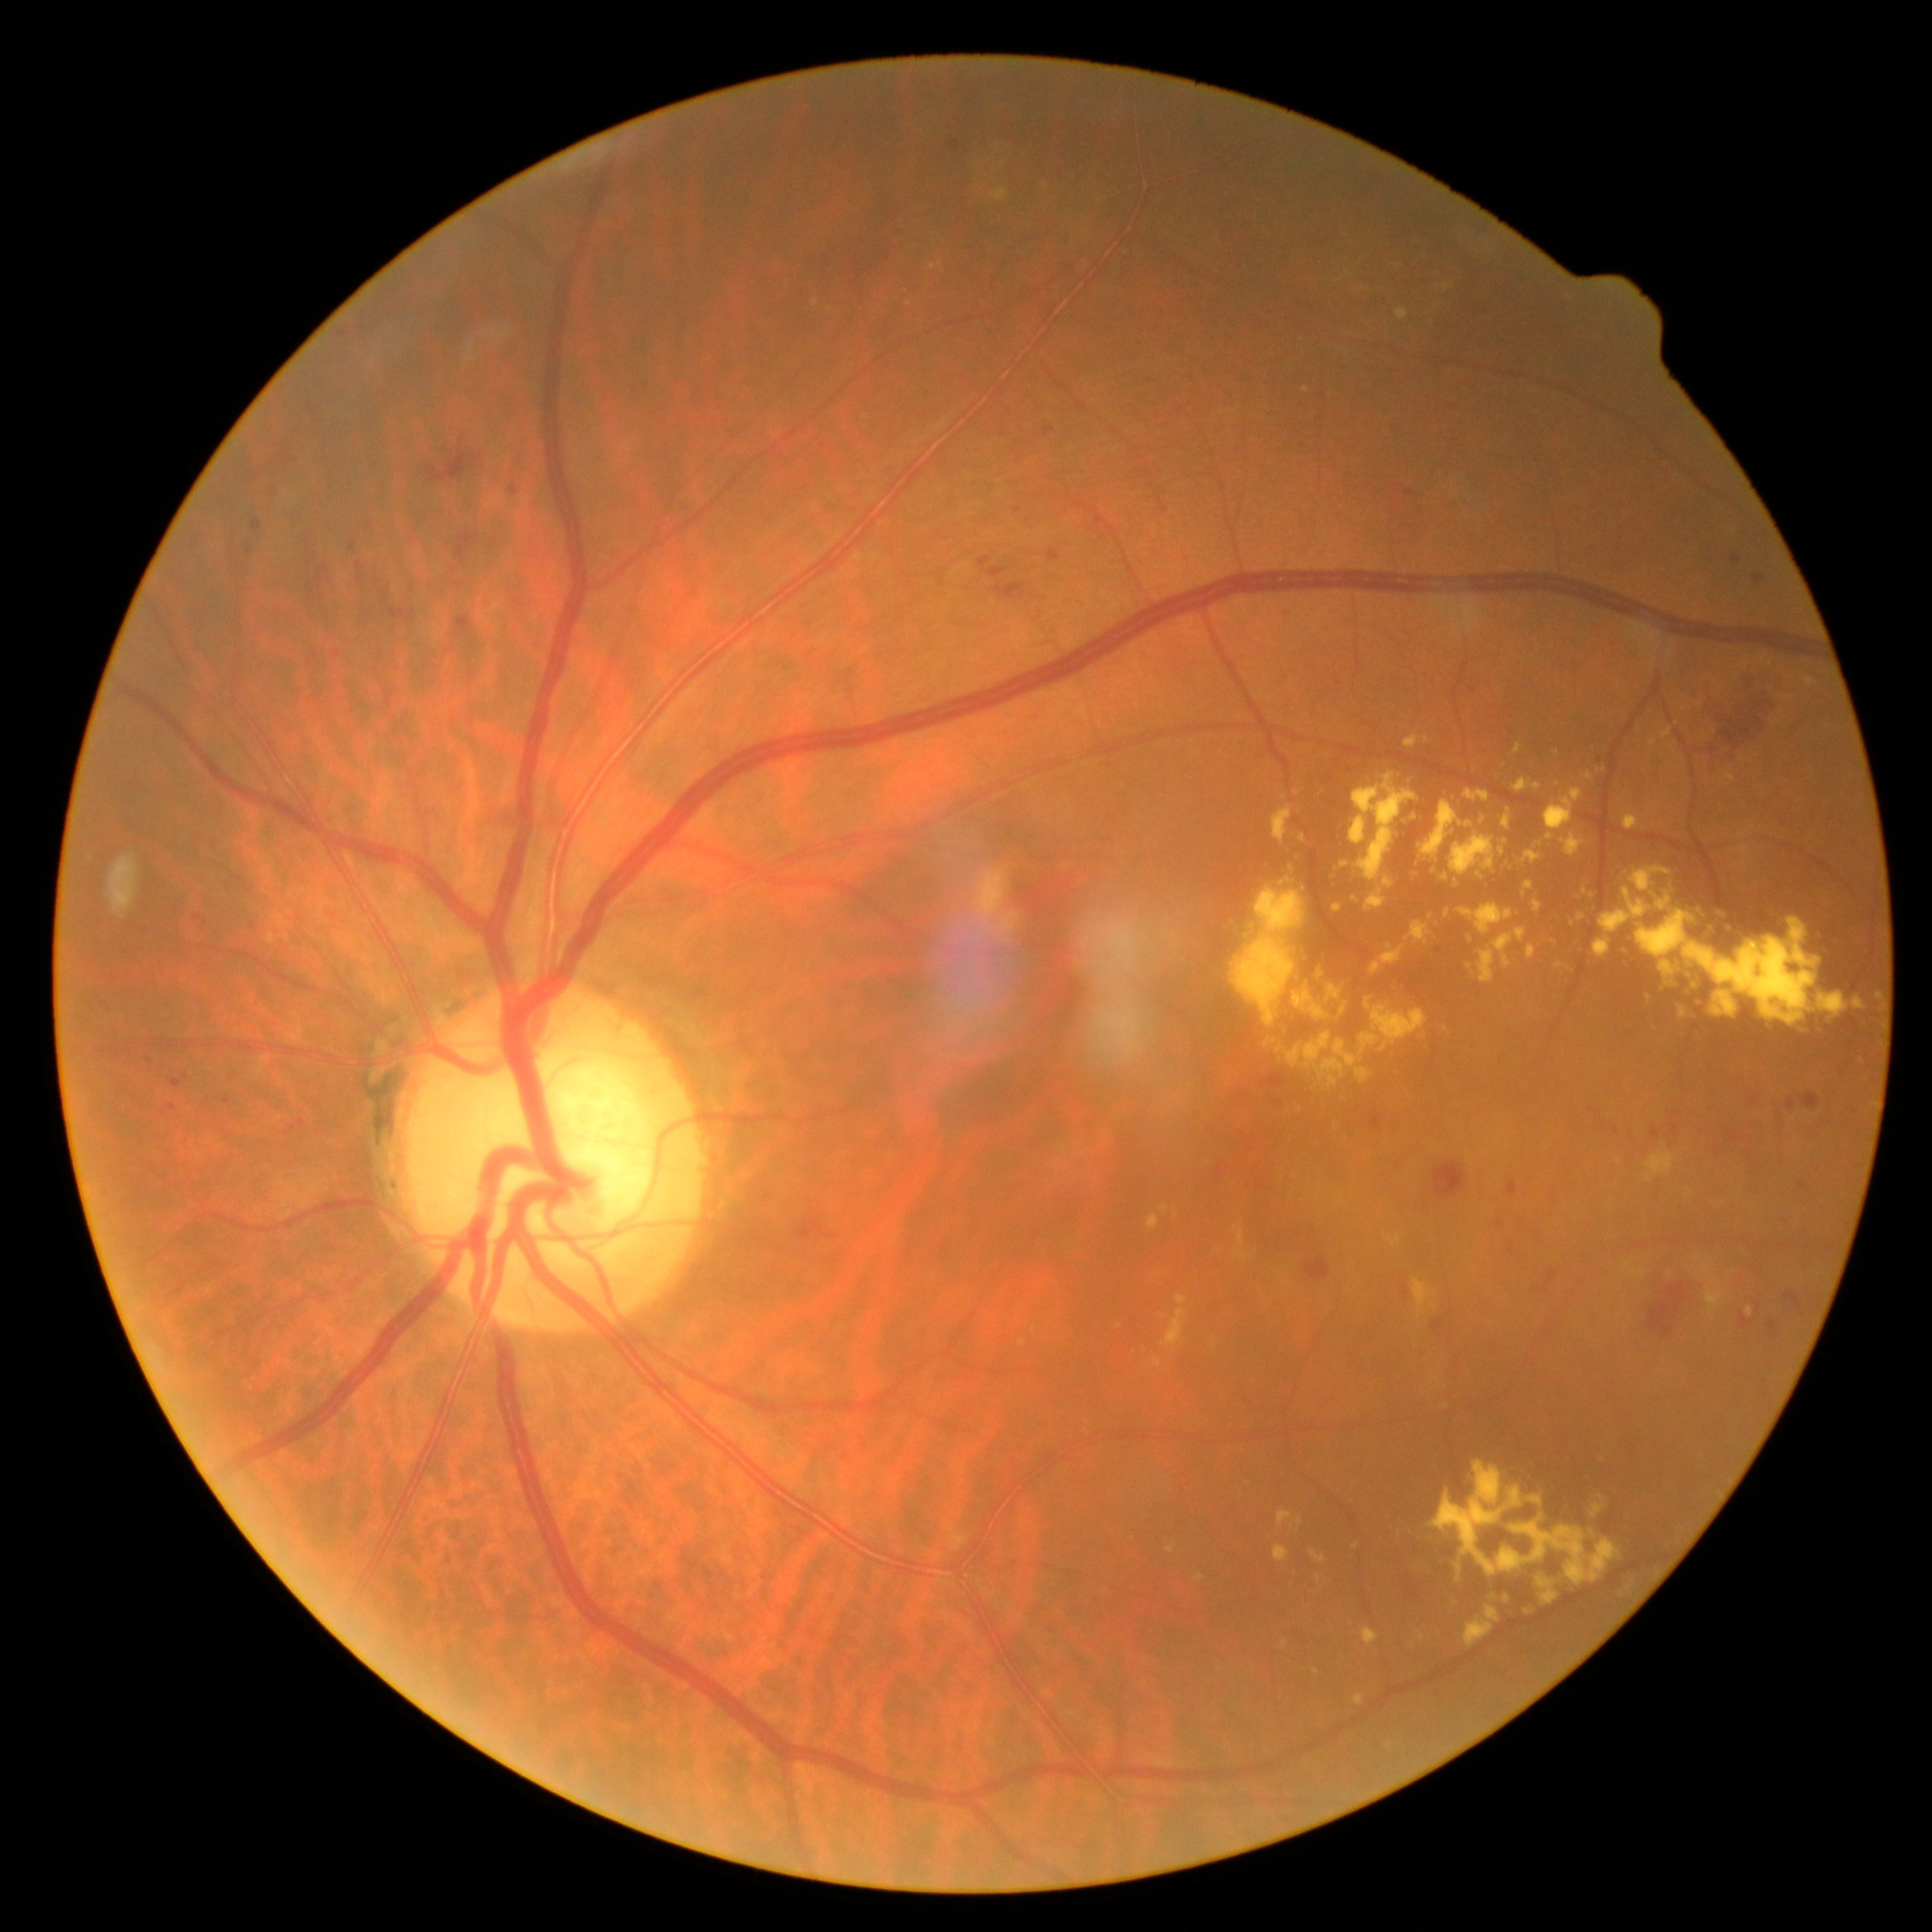
{"partial": true, "dr_grade": 2, "lesions": {"ex": [[1431, 1377, 1441, 1386], [1235, 1226, 1244, 1244], [1282, 1640, 1289, 1649], [1176, 1295, 1188, 1305], [1701, 1262, 1721, 1285], [1362, 1628, 1379, 1646], [972, 867, 1019, 943], [1404, 734, 1418, 749], [1196, 1573, 1205, 1580]], "ex_small": [[1619, 1160], [1447, 287], [952, 1529], [1426, 739], [1745, 668], [1445, 1029], [1681, 758], [1339, 1206]], "he": [[1215, 1167, 1226, 1179], [946, 139, 960, 154], [1690, 1129, 1707, 1139], [807, 654, 816, 657], [282, 459, 290, 465], [1728, 1134, 1741, 1143], [311, 586, 321, 592], [318, 567, 329, 574], [1303, 1256, 1332, 1280], [1644, 1253, 1707, 1339], [338, 328, 349, 337], [1404, 489, 1413, 497], [389, 609, 415, 621], [1786, 1292, 1802, 1310]], "he_small": [[177, 910], [252, 482], [1539, 1240]]}}